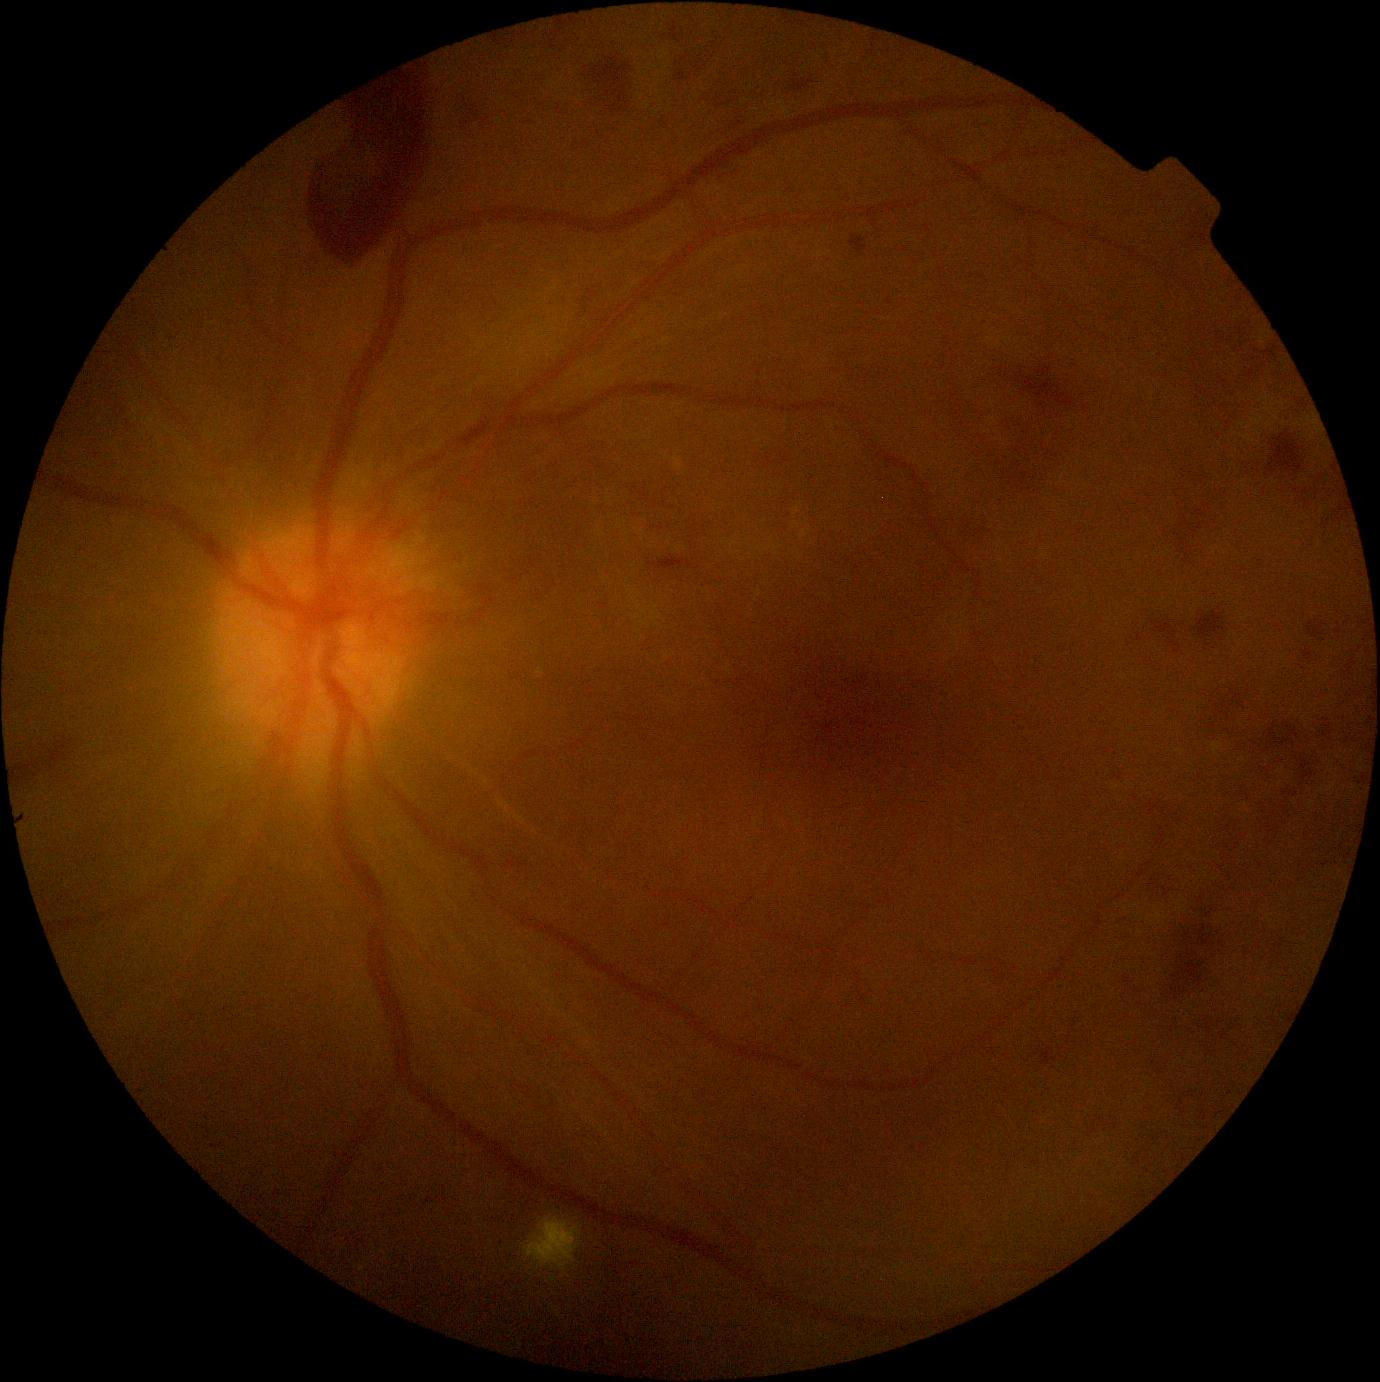 DR: grade 4 (PDR).